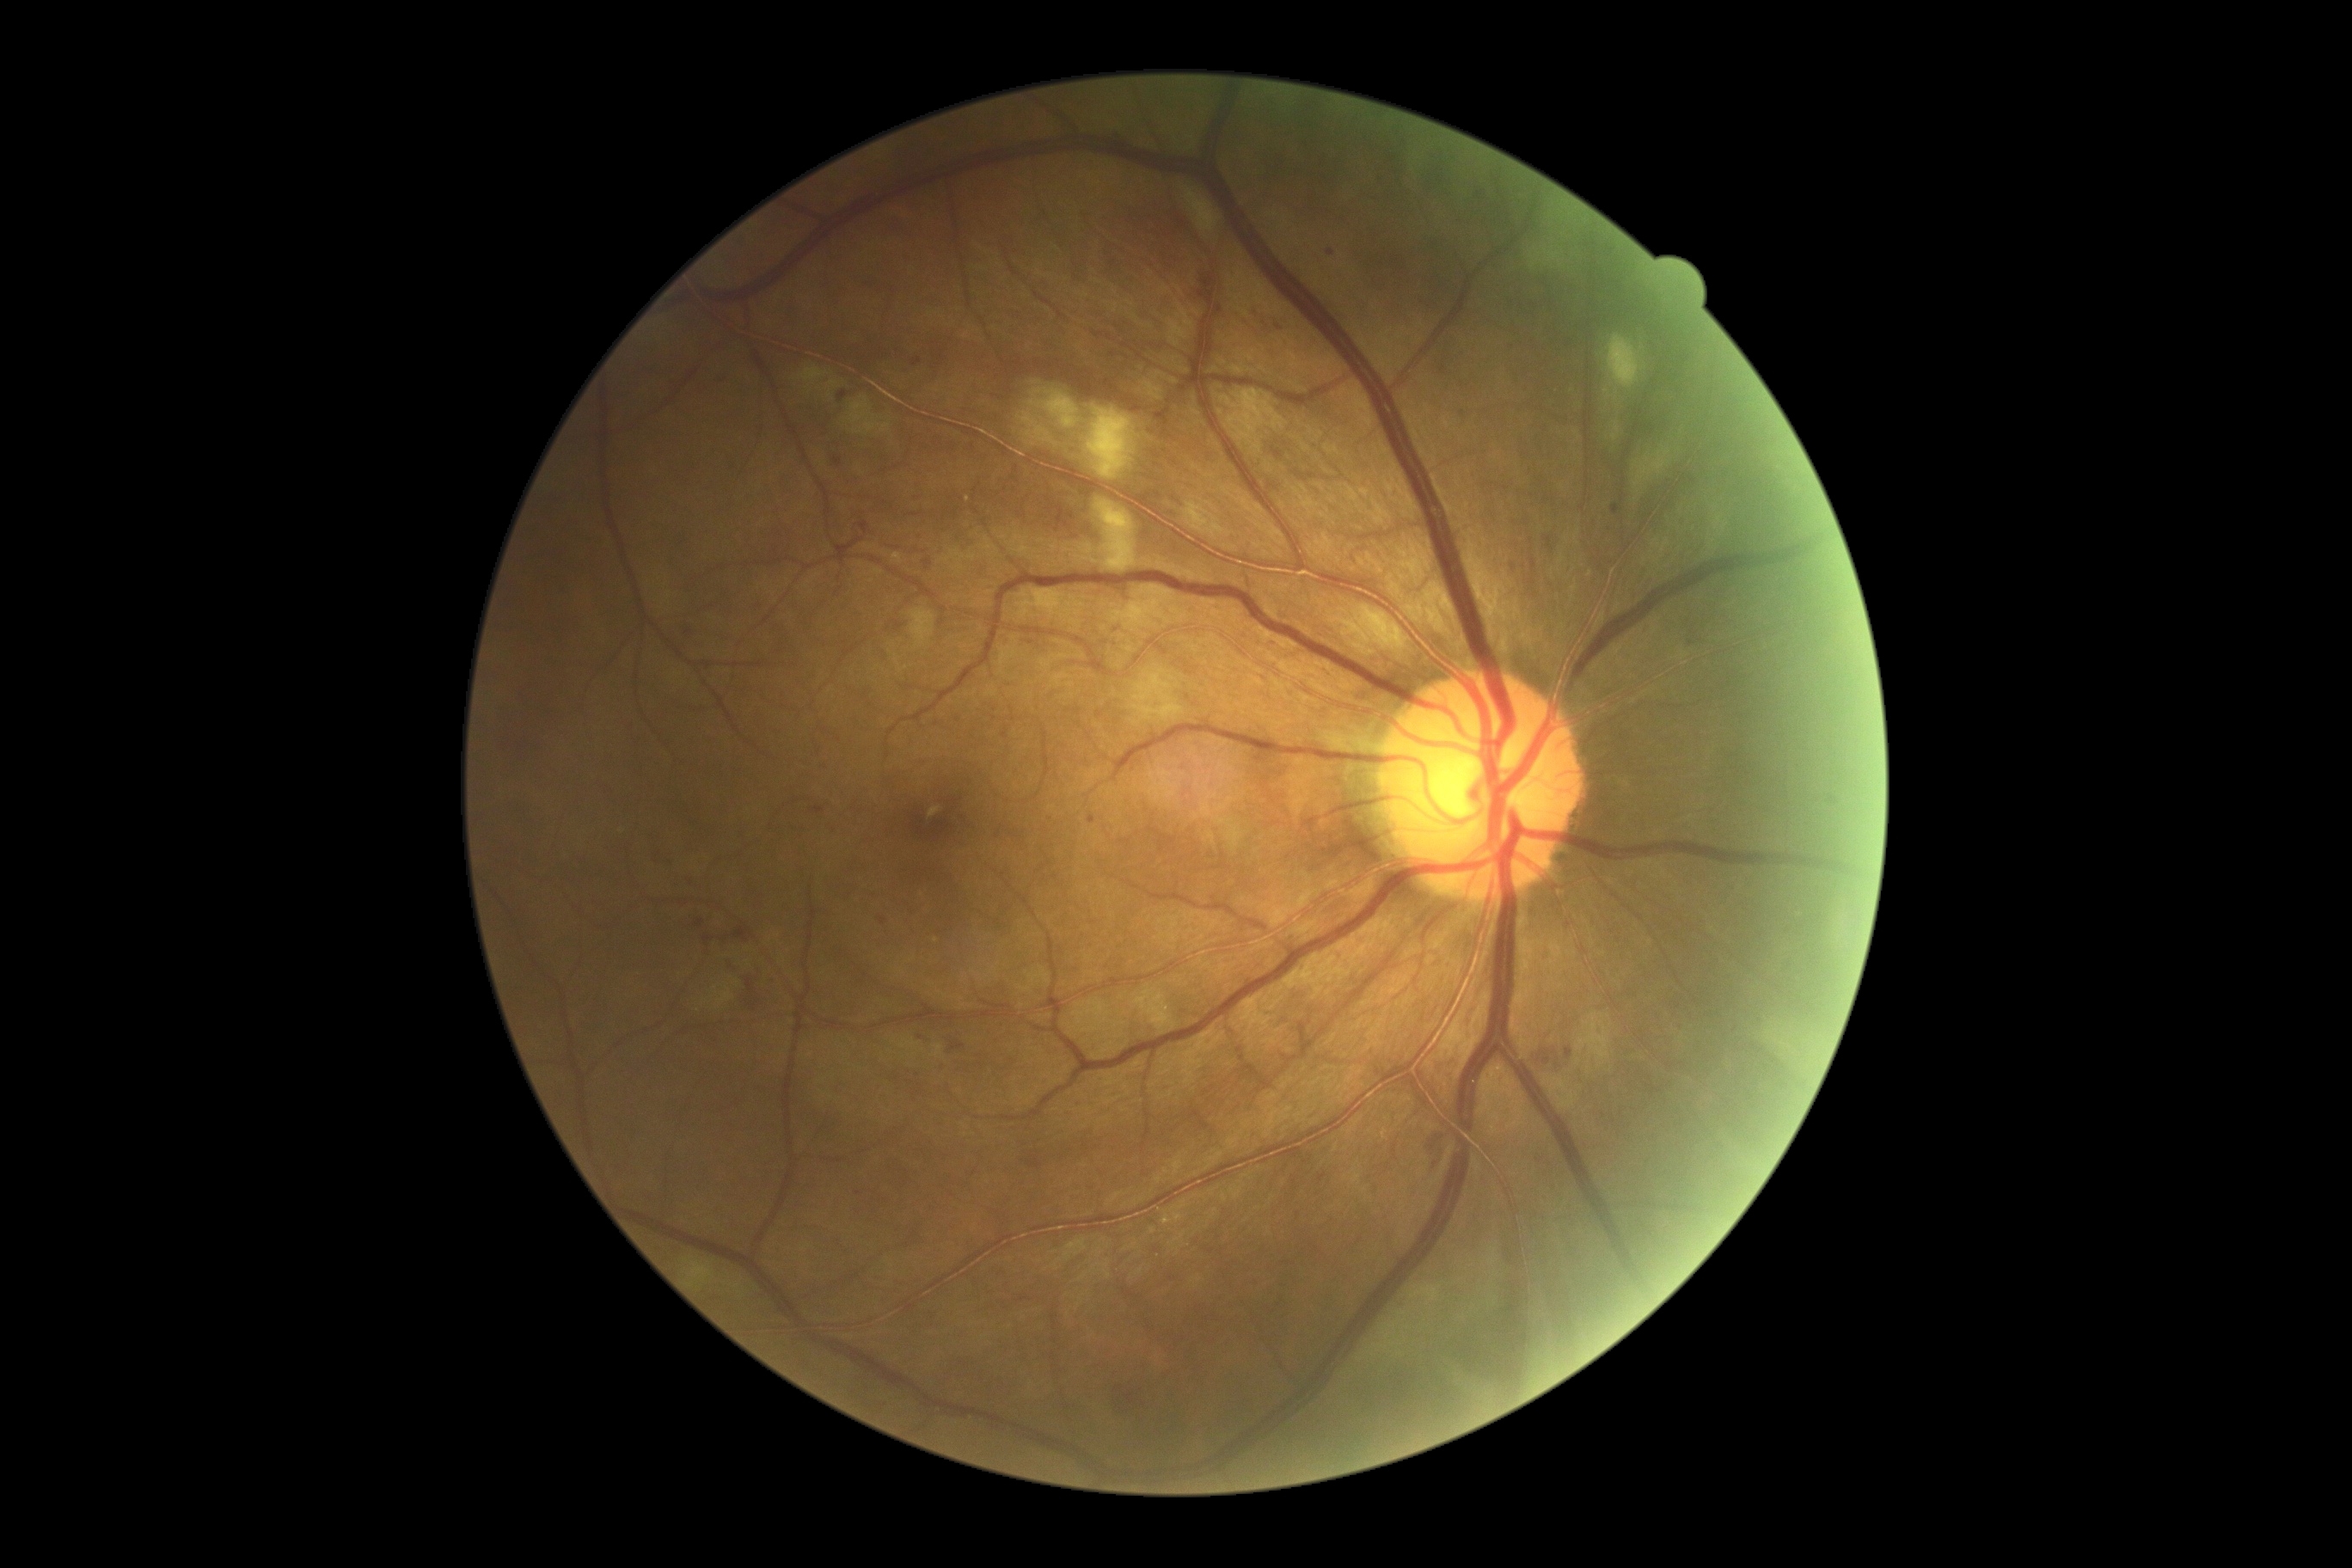
retinopathy grade = 2/4.